2048 x 1536 pixels, captured on a Forus 3Nethra Classic fundus camera, color fundus photograph.
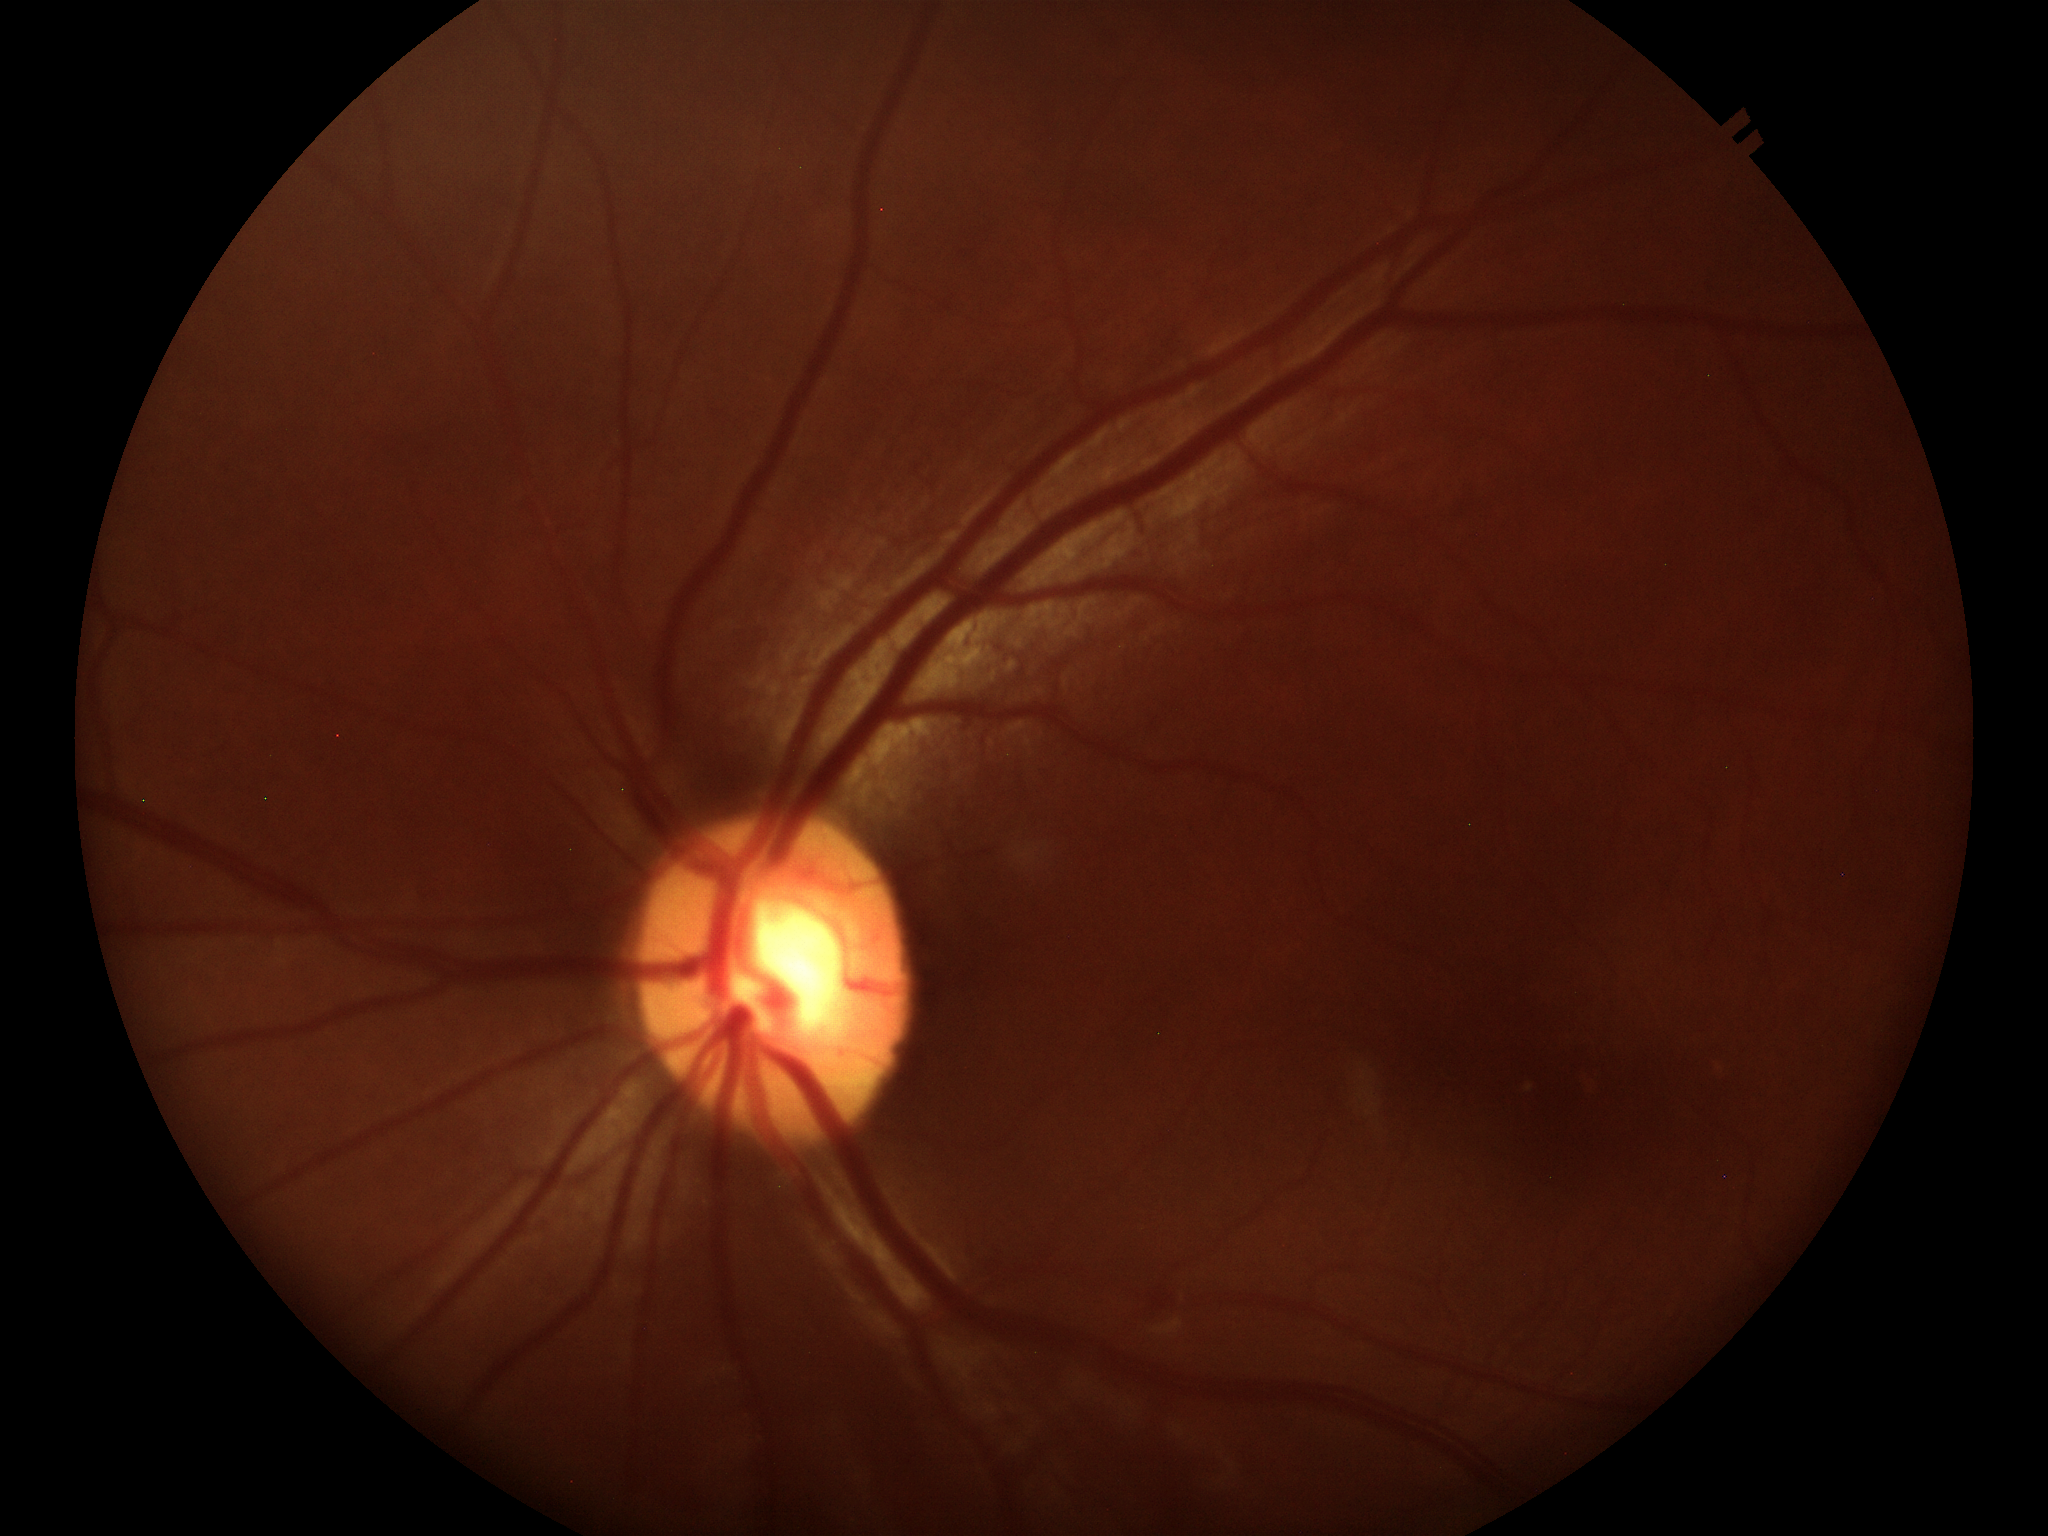
Not suspicious for glaucoma. Vertical C/D ratio: 0.54.